45-degree field of view · color fundus photograph:
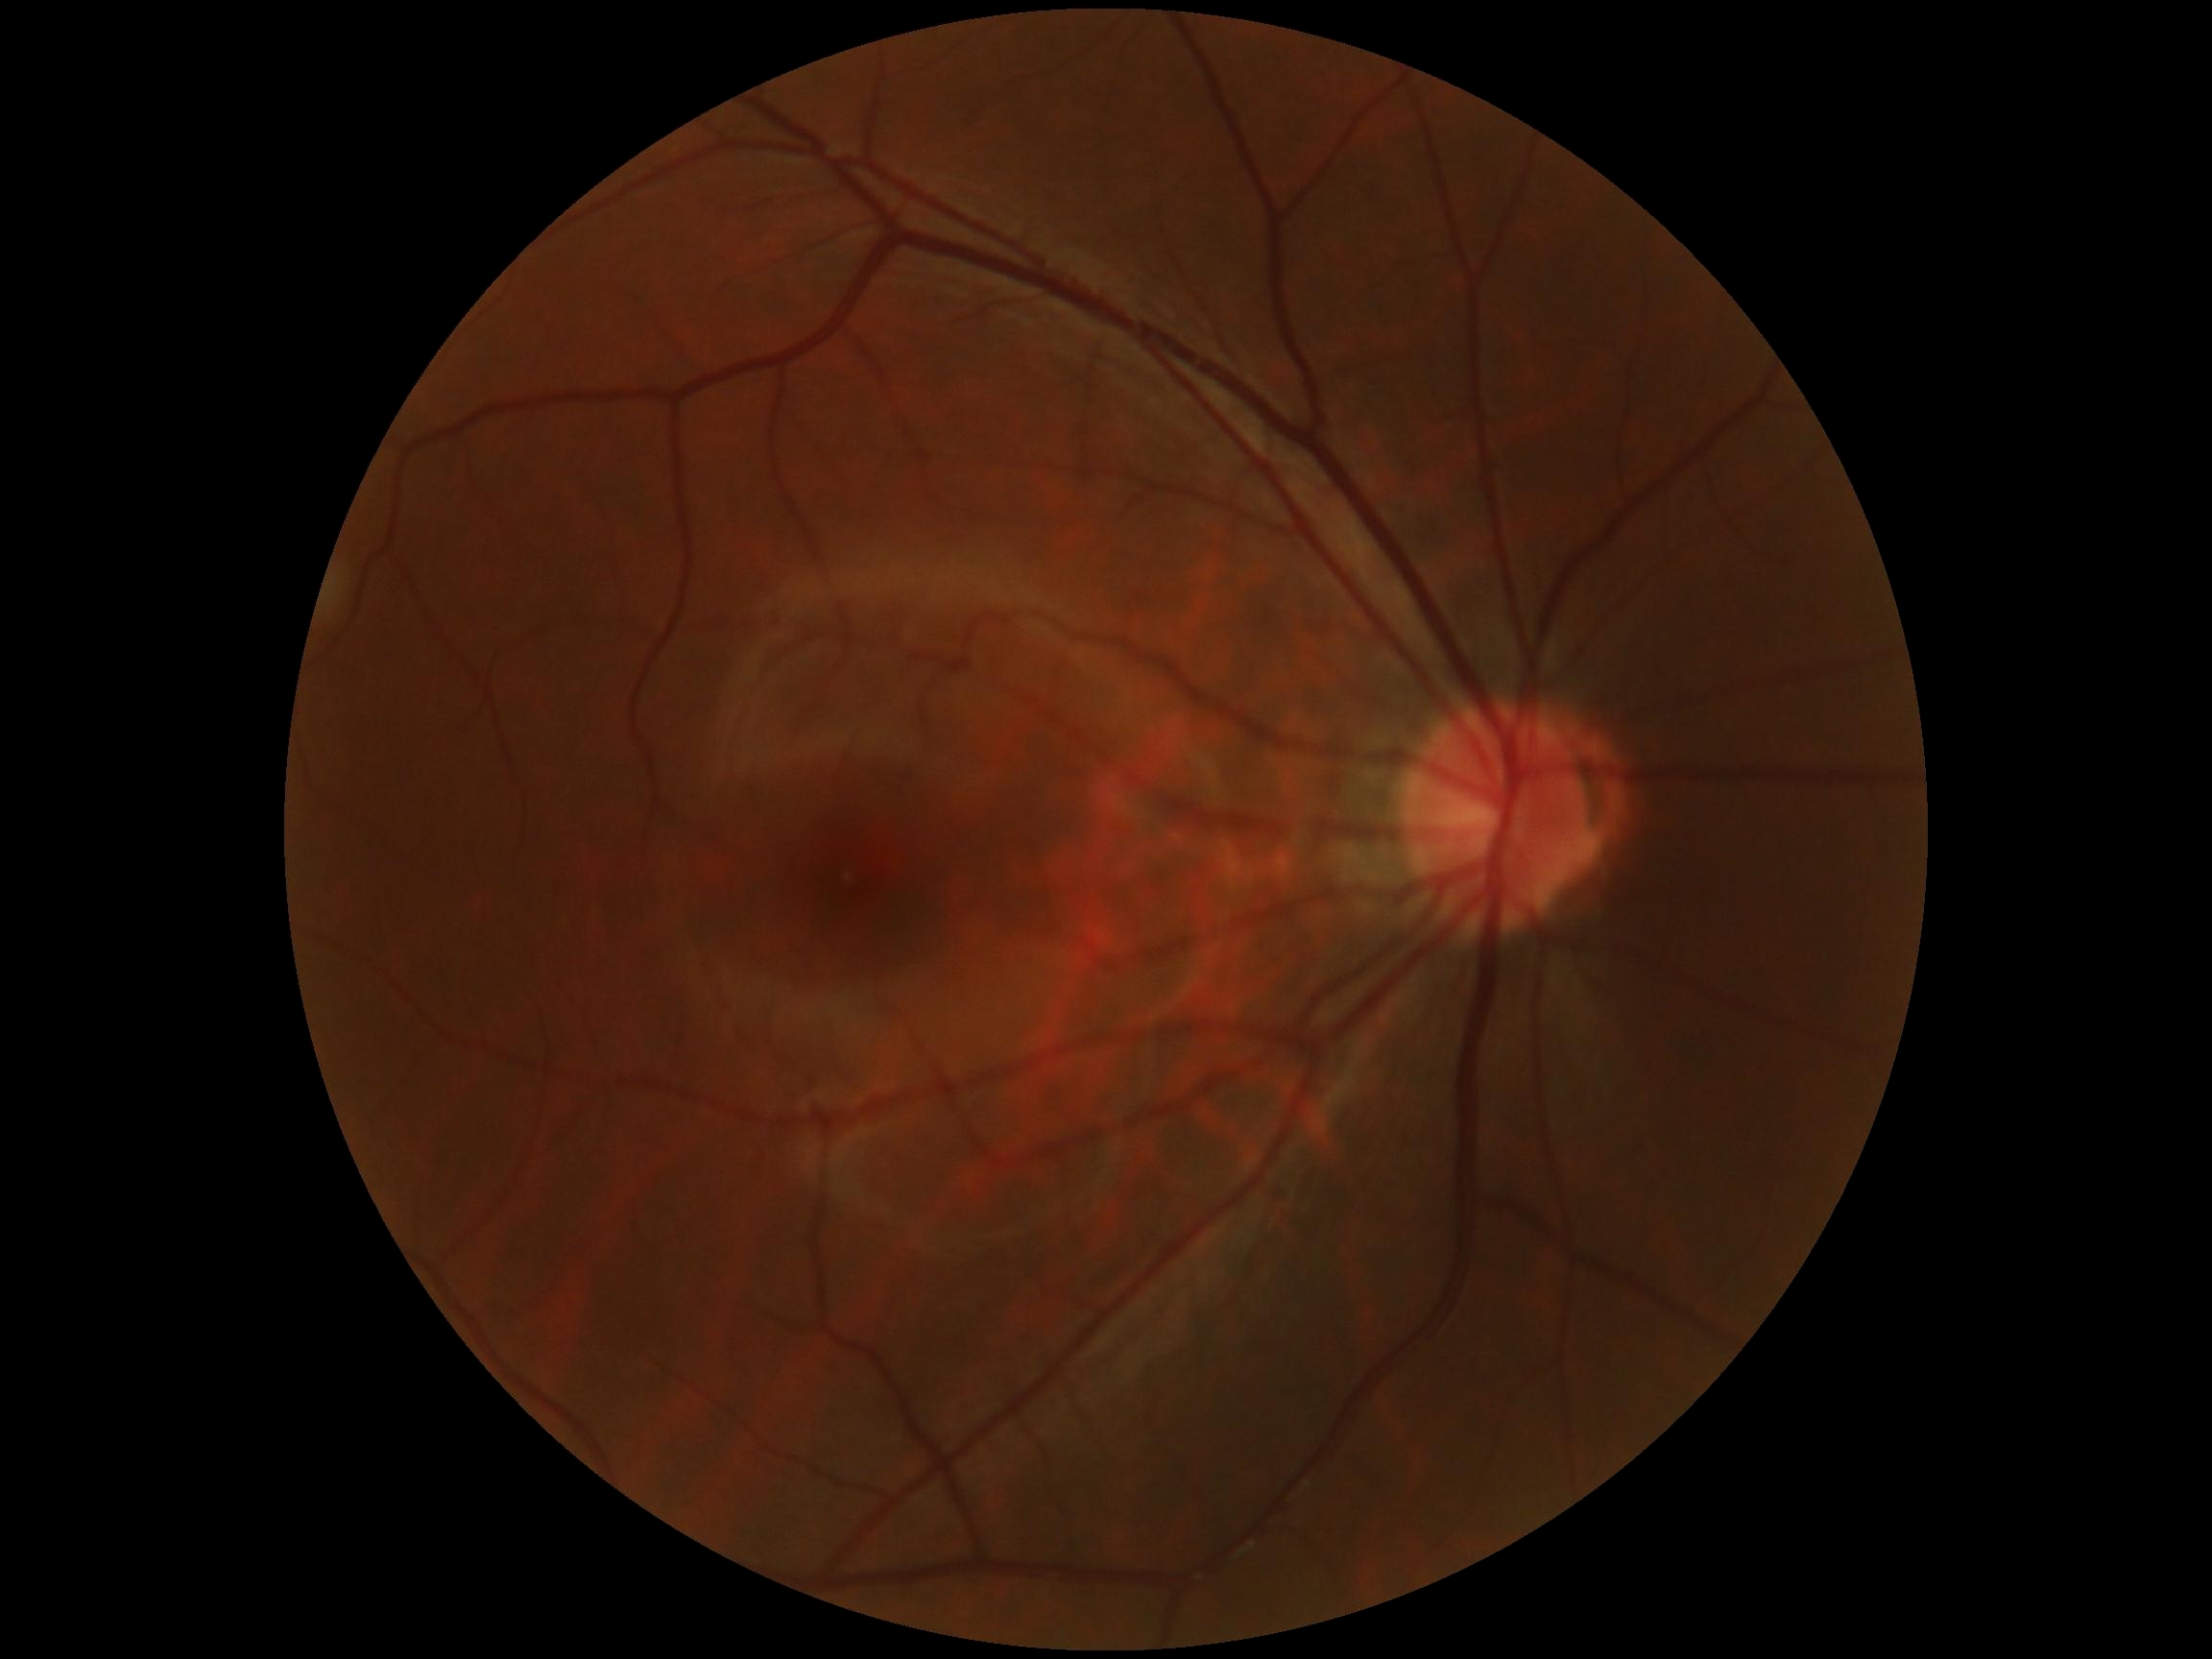

DR: no apparent retinopathy (grade 0).